45-degree field of view; color fundus photograph:
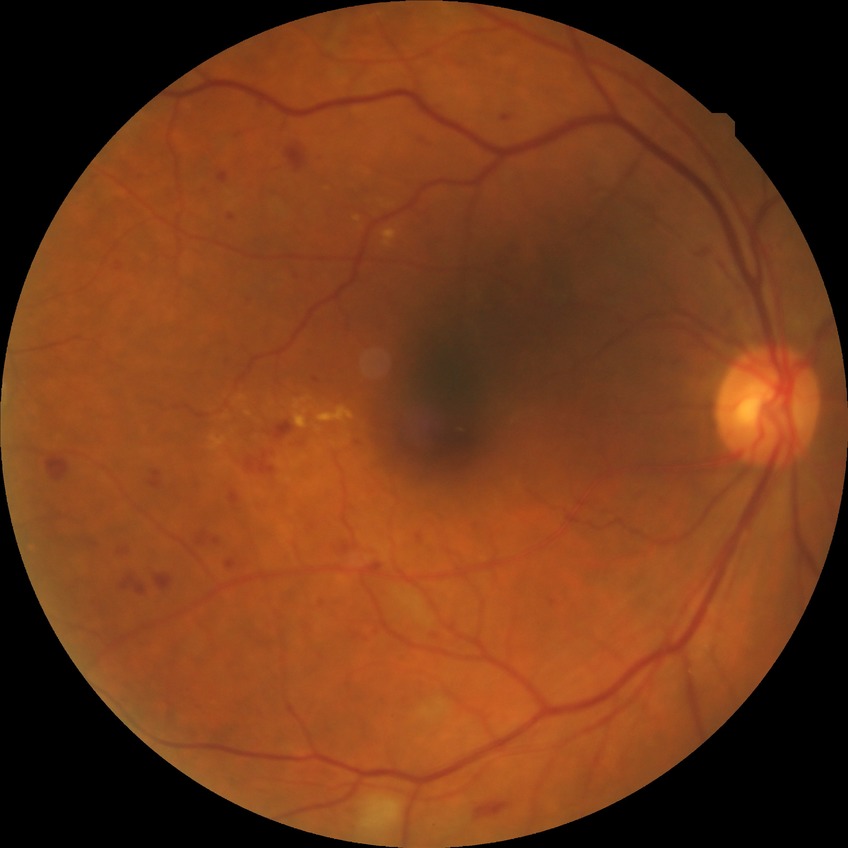

Diabetic retinopathy (DR): PPDR (pre-proliferative diabetic retinopathy).